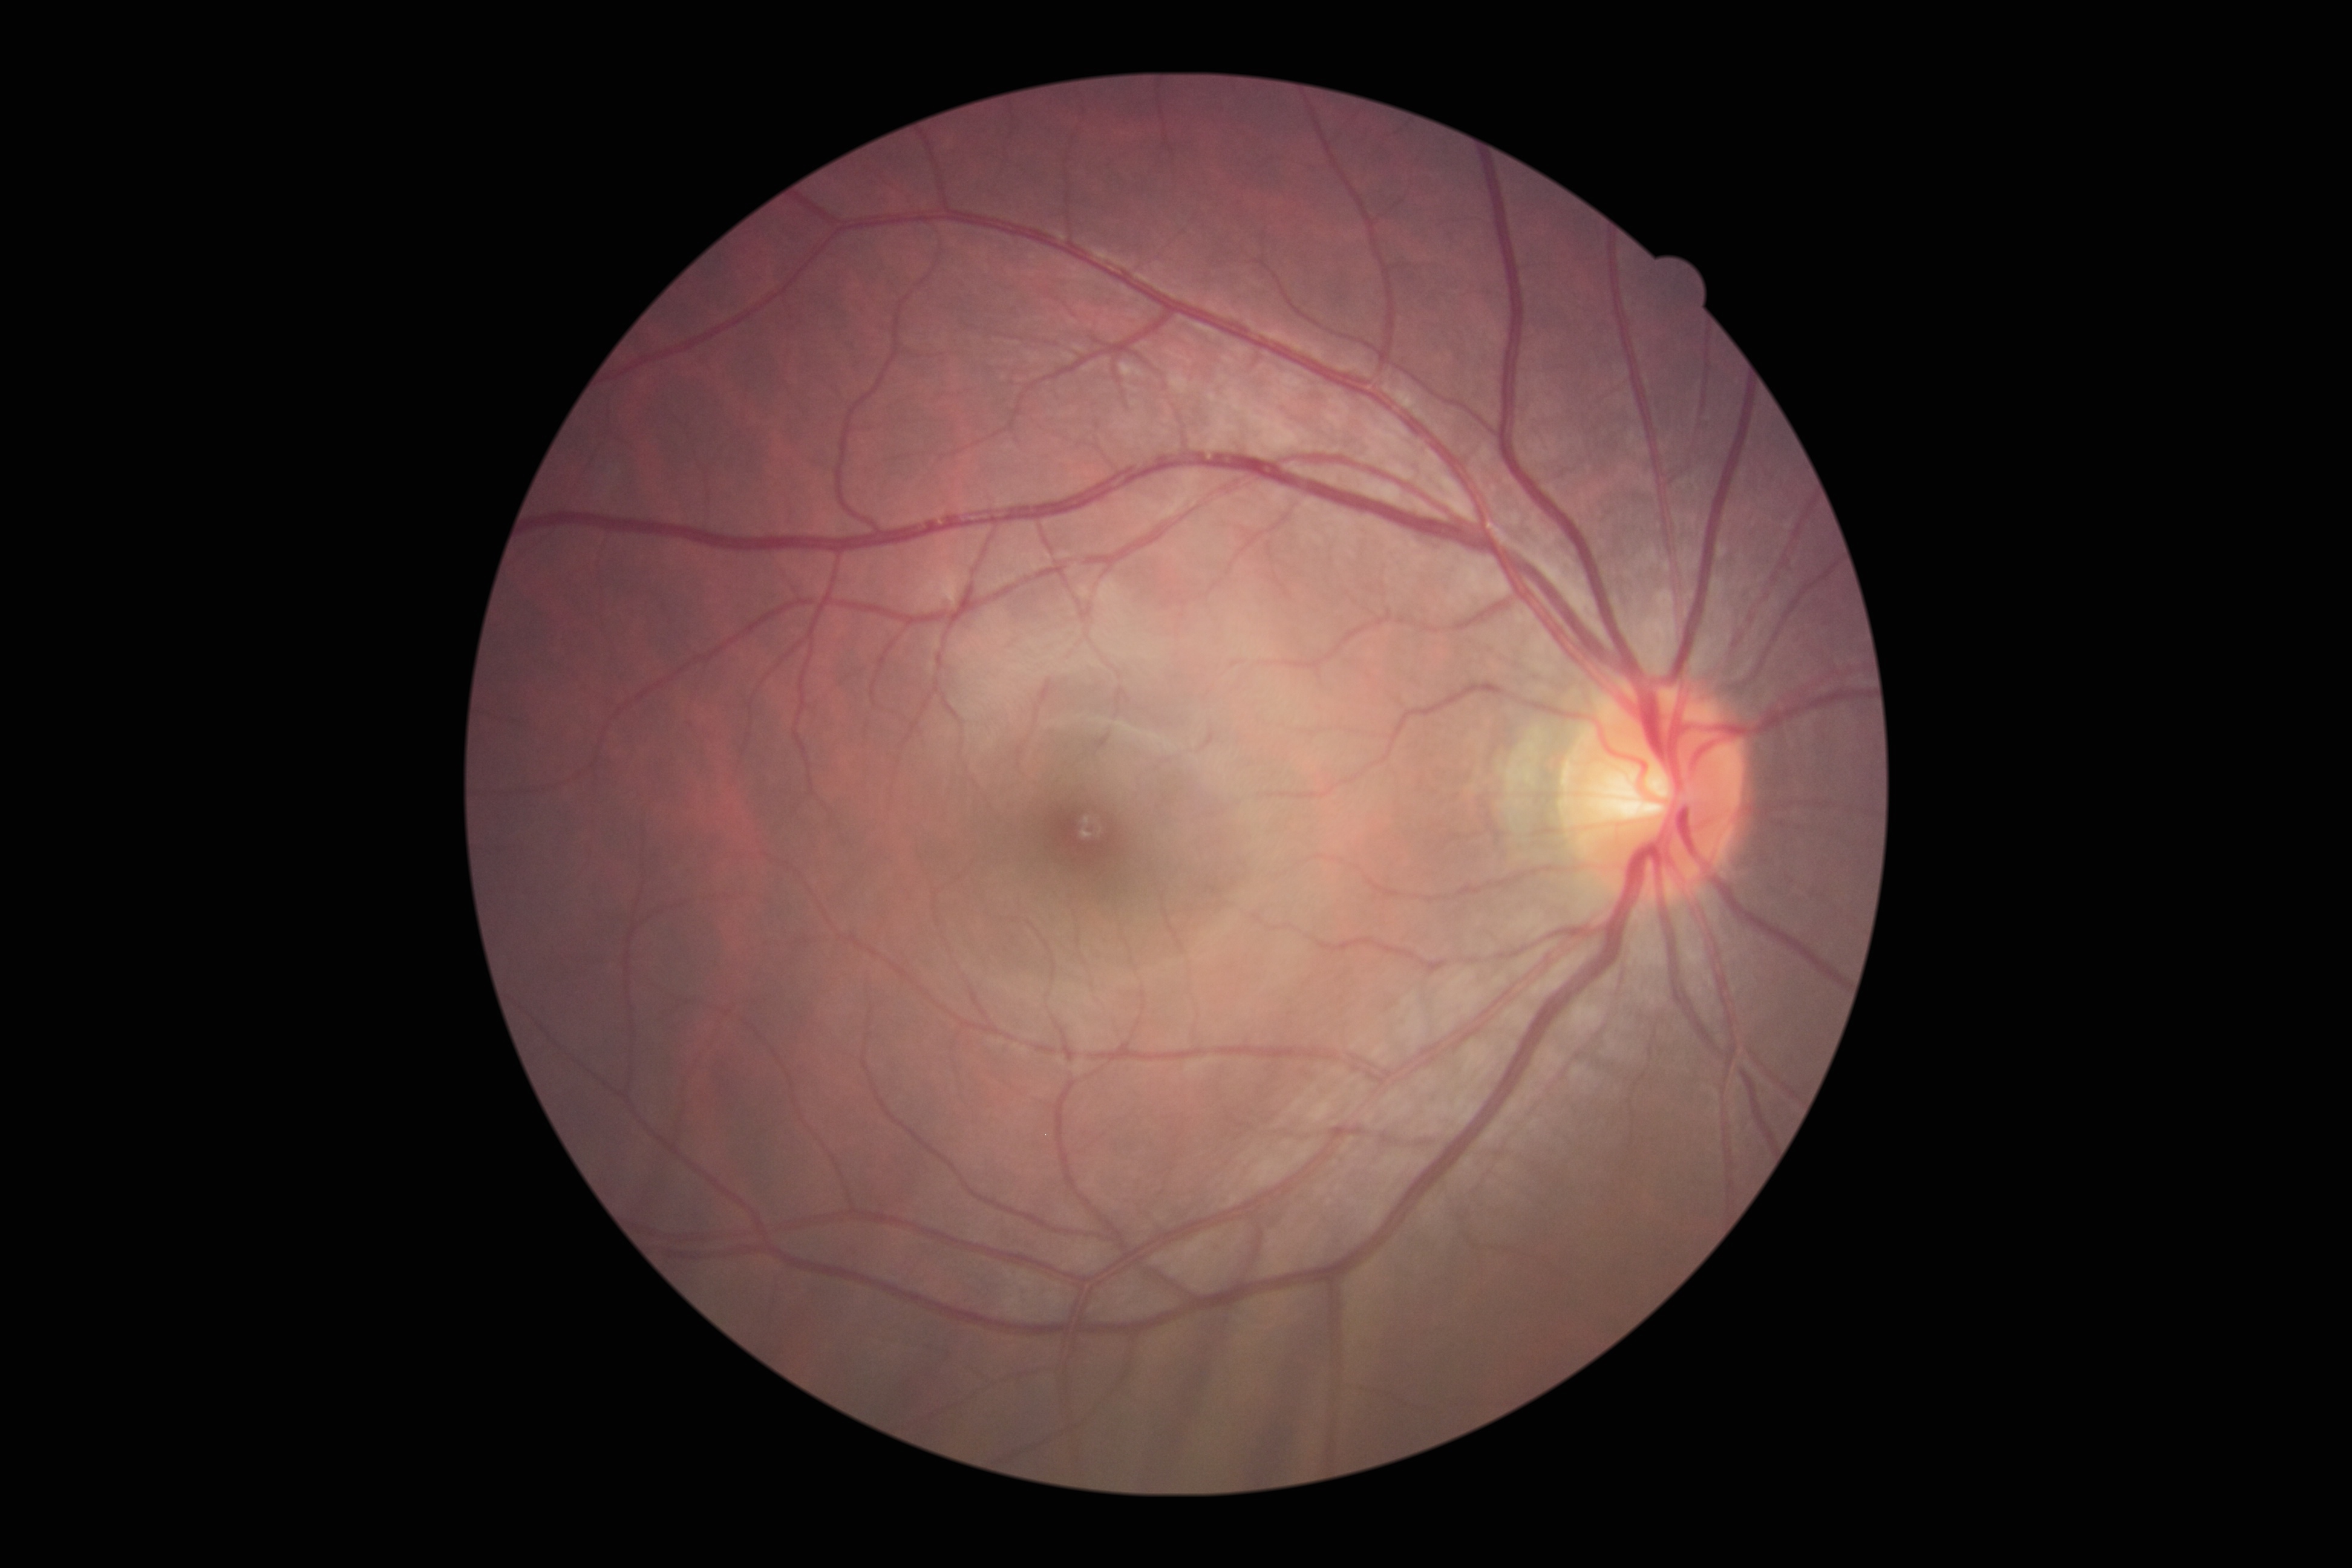

DR is no apparent retinopathy (grade 0).